45° field of view · modified Davis grading · without pupil dilation
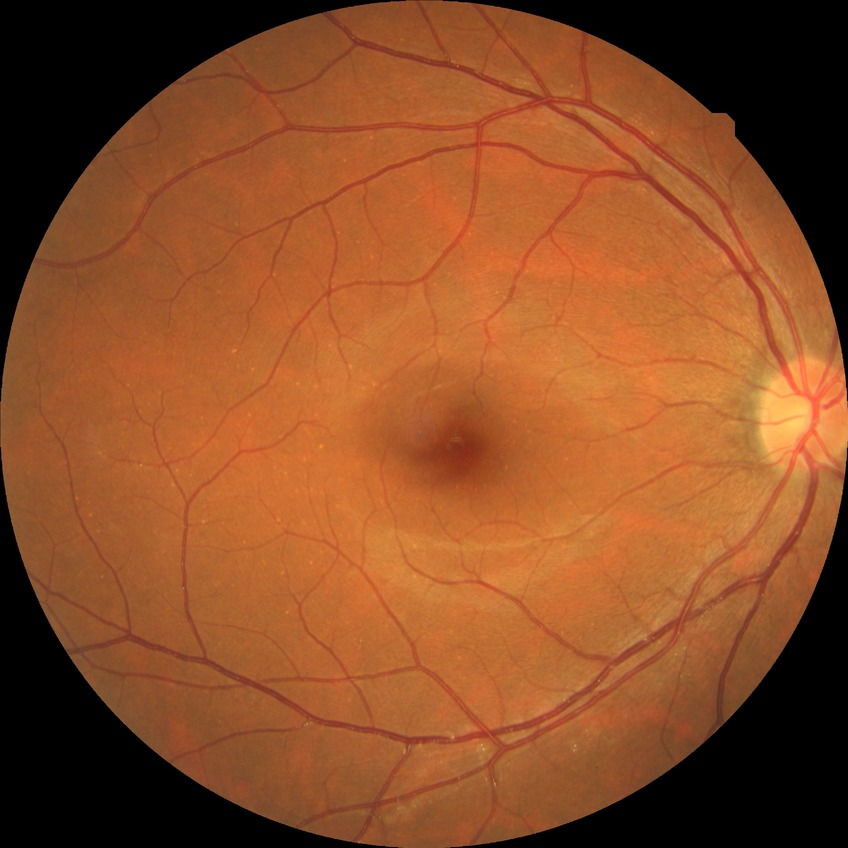 DR: NDR.